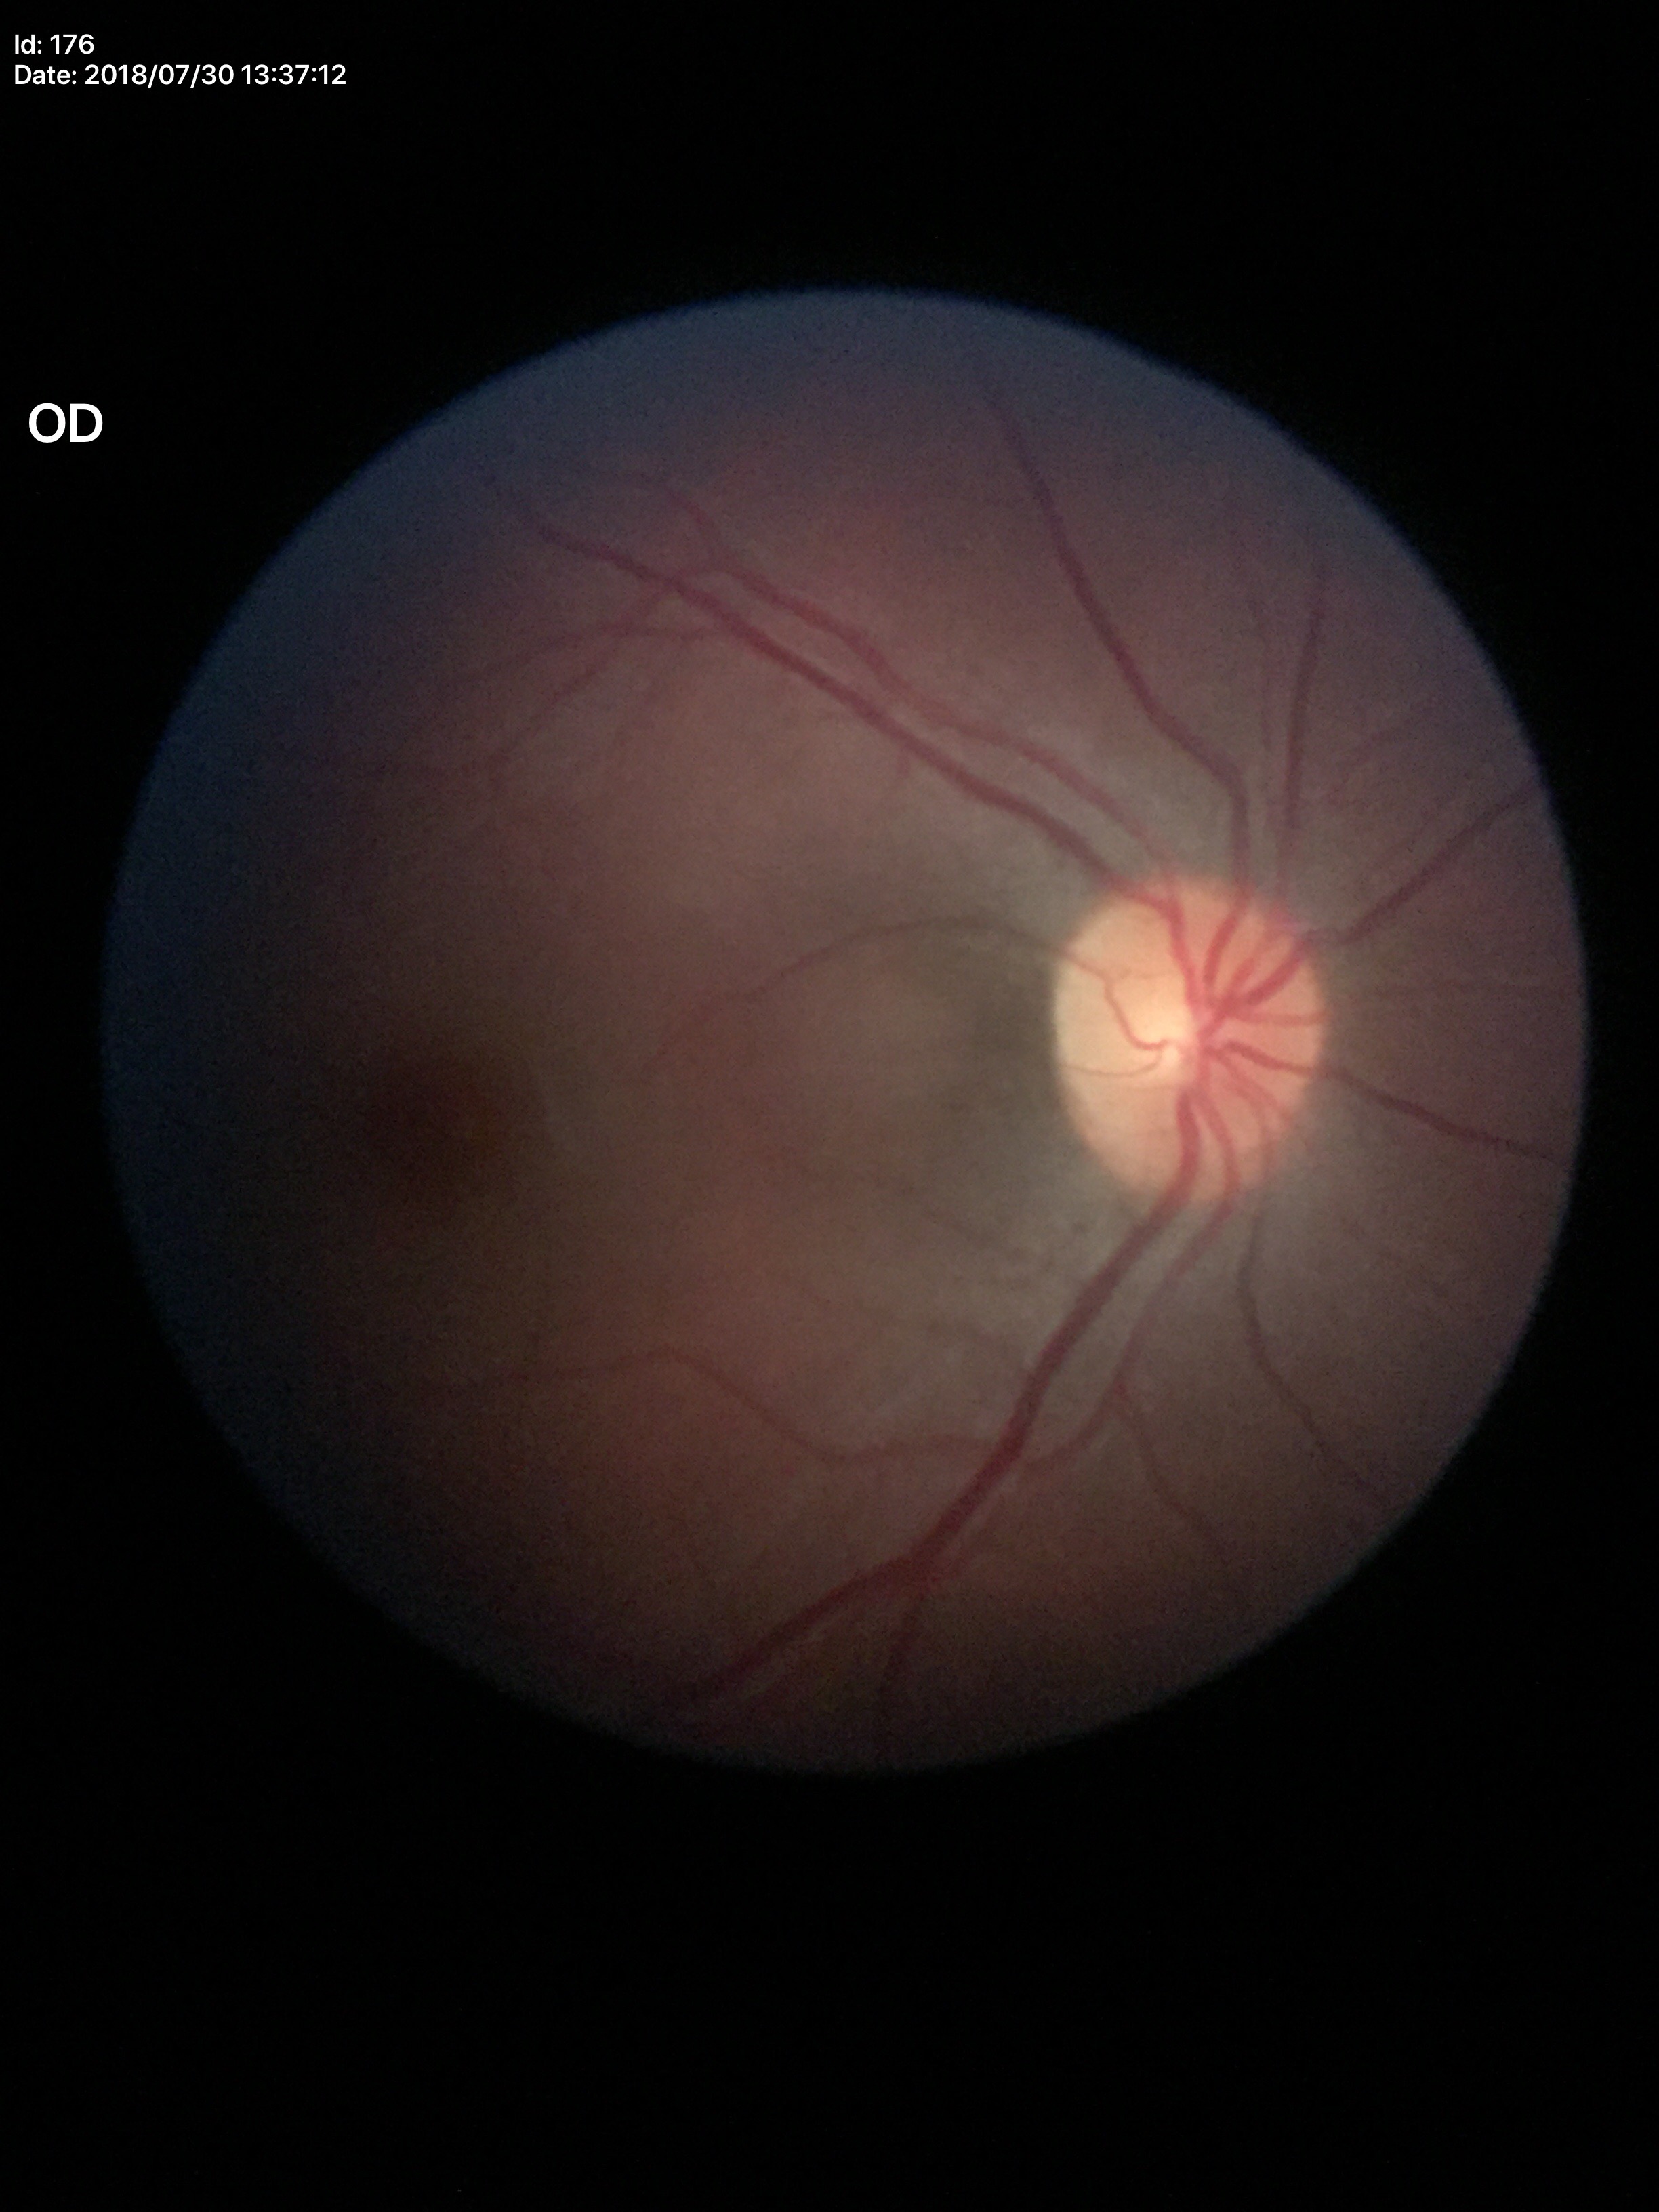

Glaucoma decision: no suspicious findings.
VCDR is 0.42.